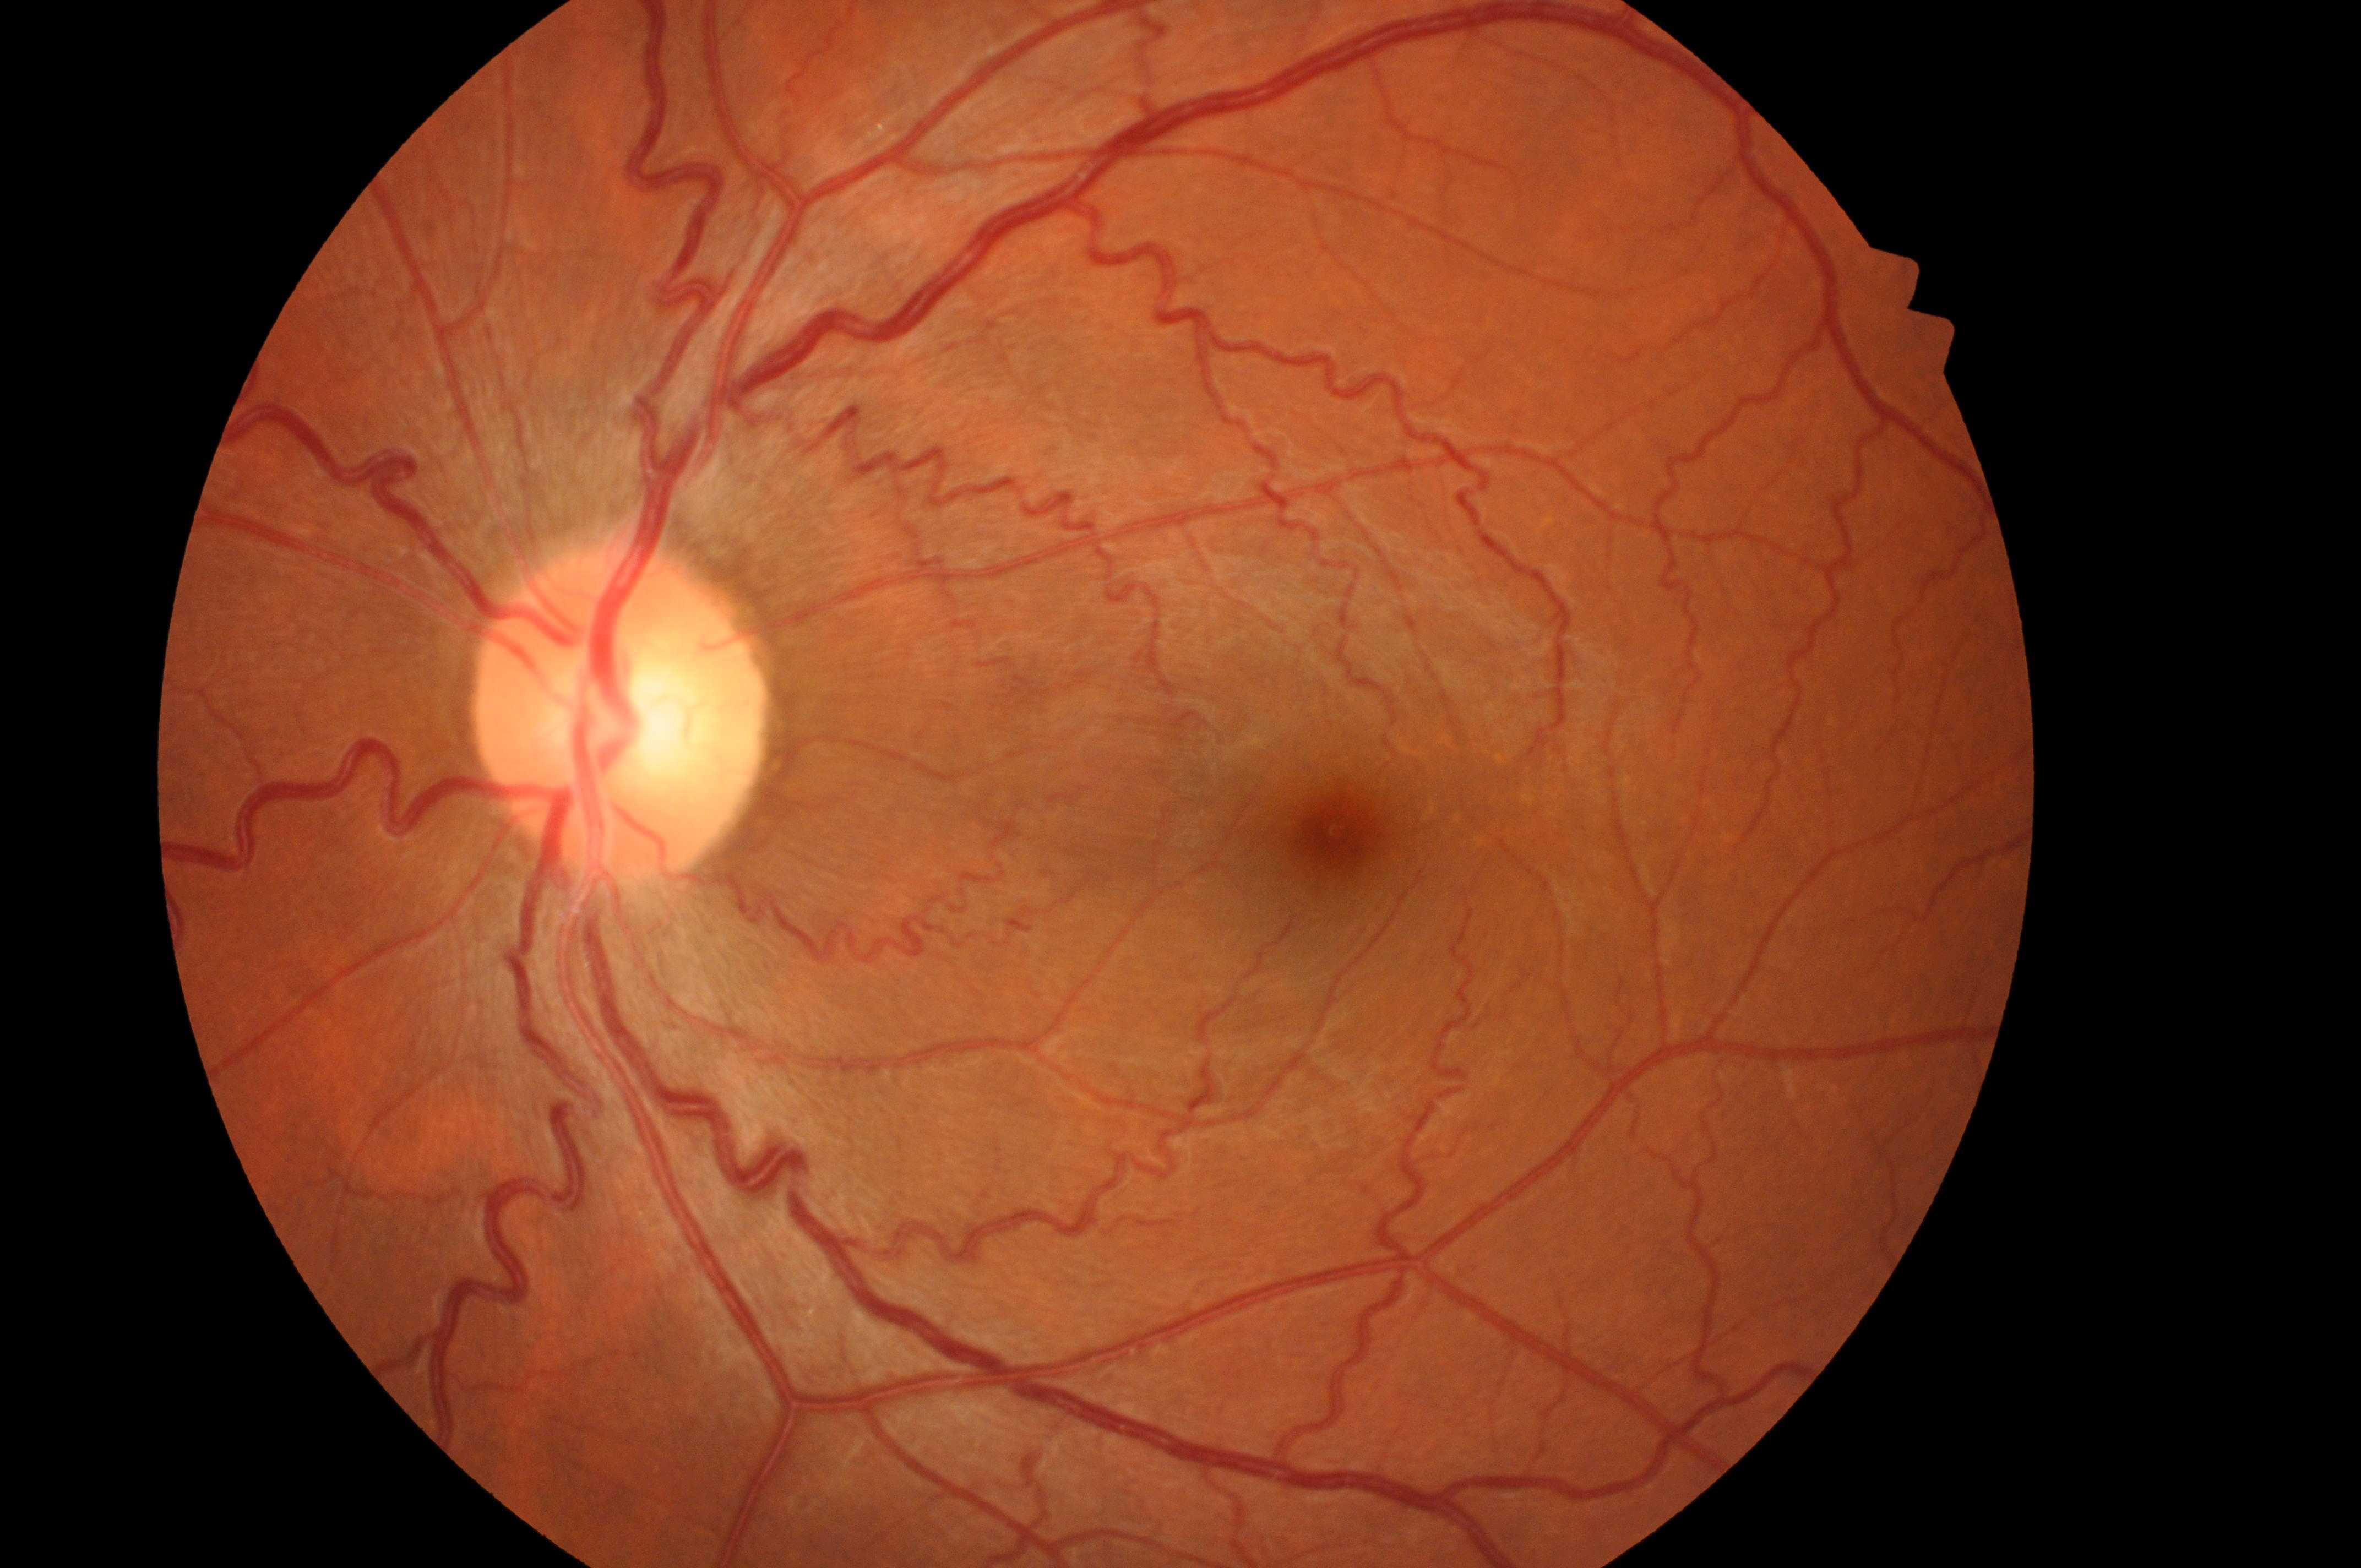 Optic nerve head located at (x: 610, y: 727).
The image shows the left eye.
Diabetic macular edema is 0/2 — no apparent hard exudates.
The macula center is at (x: 1343, y: 833).
Retinopathy grade is 0 — no visible signs of diabetic retinopathy.